Camera: Clarity RetCam 3 (130° FOV) · 640x480 · infant wide-field retinal image — 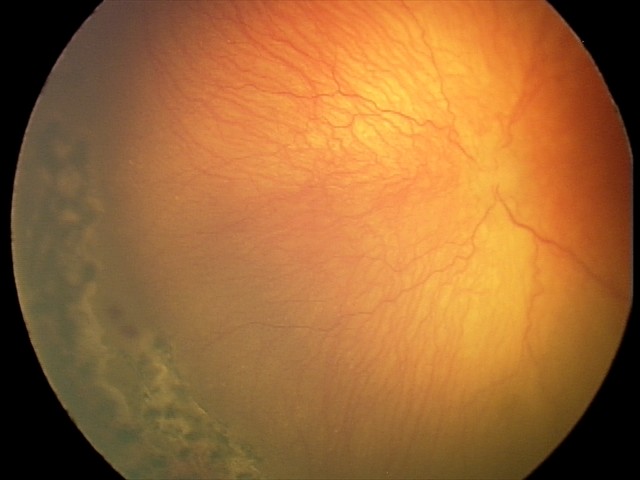 Q: Is plus disease present?
A: plus disease
Q: What is the screening diagnosis?
A: aggressive retinopathy of prematurity — rapidly progressive severe ROP with prominent plus disease, often without classic stage progression